798 by 752 pixels · fundus photo.
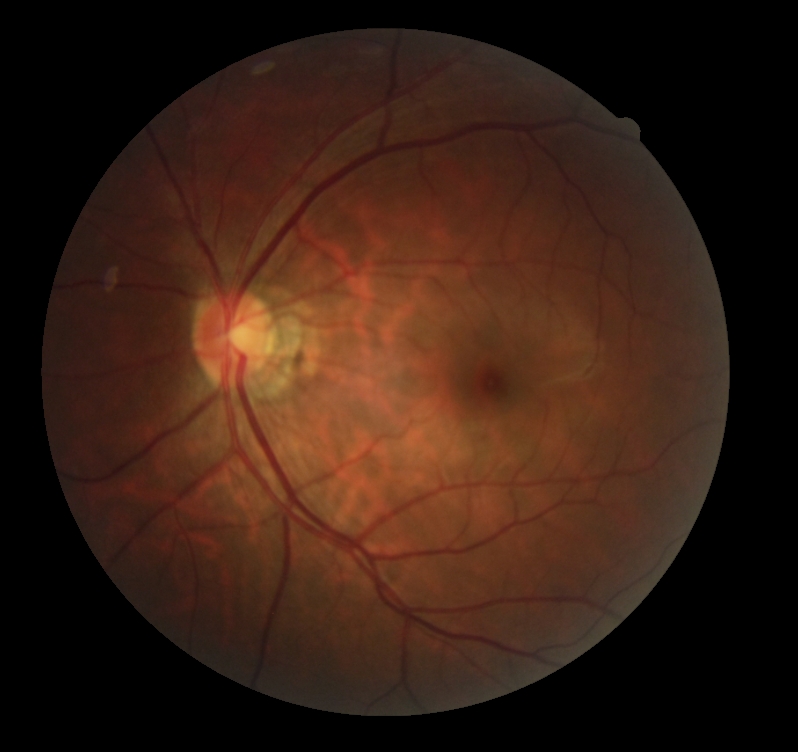
DR grade is 0 (no apparent retinopathy).